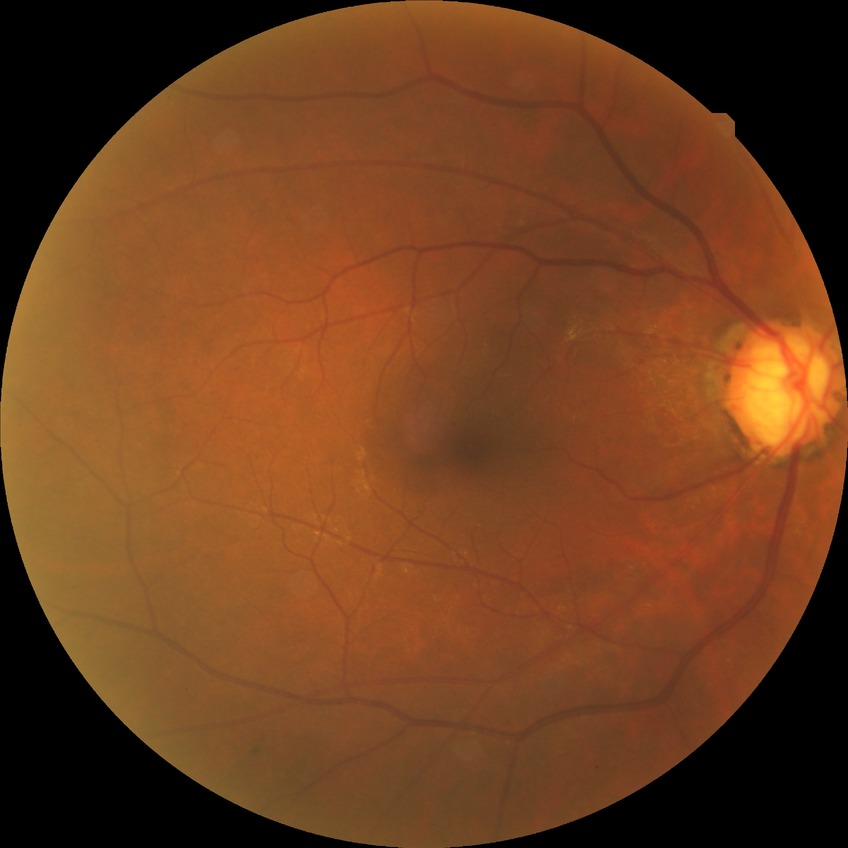

DR stage: NDR.